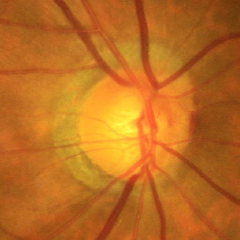
Early glaucoma.